Nonmydriatic. 45° field of view. Graded on the modified Davis scale:
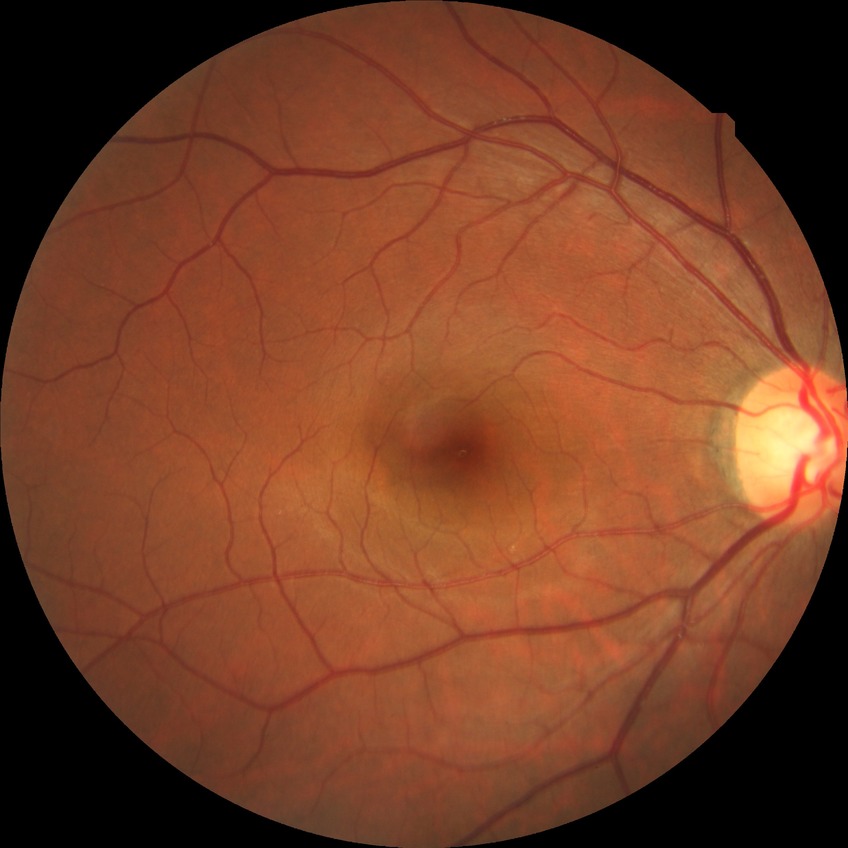

DR stage: NDR.
No diabetic retinal disease findings.